Image size 848x848:
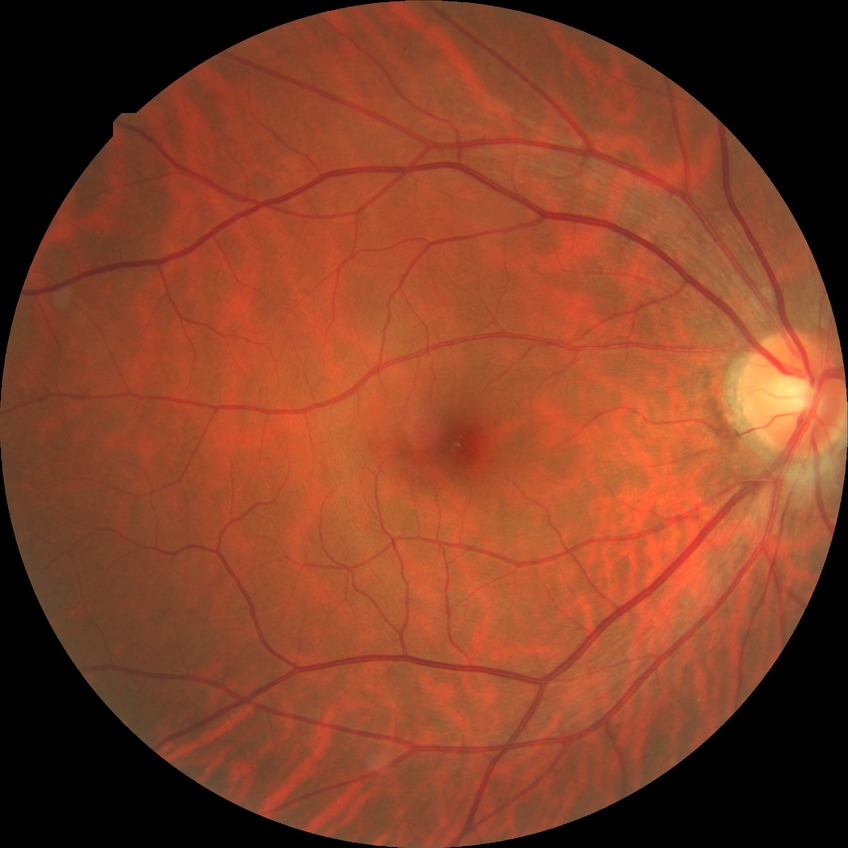

Diabetic retinopathy (DR) is NDR (no diabetic retinopathy).